Modified Davis grading.
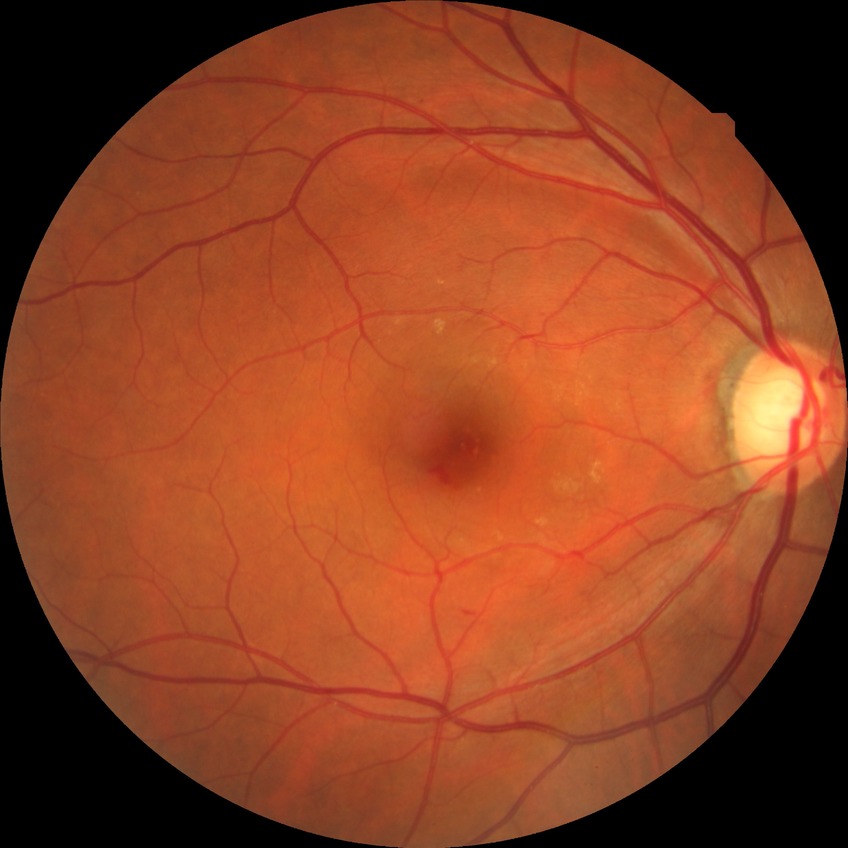
Modified Davis grading is no diabetic retinopathy.